1240x1240px · wide-field fundus photograph from neonatal ROP screening.
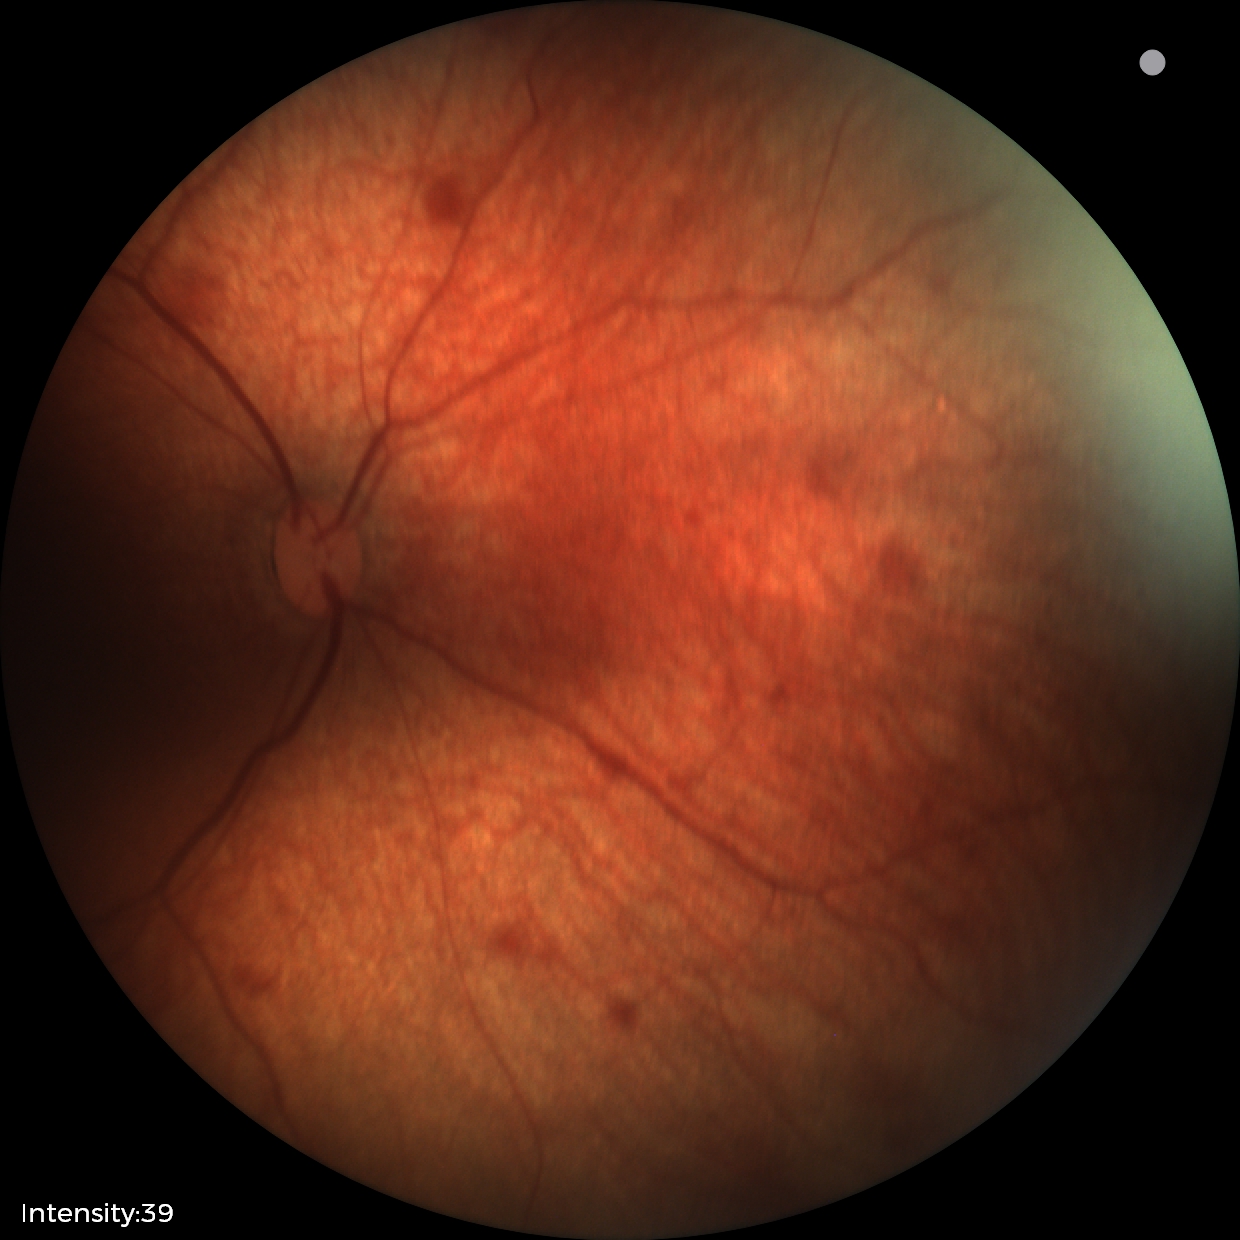 Screening examination consistent with retinal hemorrhages.